640 x 480 pixels; pediatric retinal photograph (wide-field) — 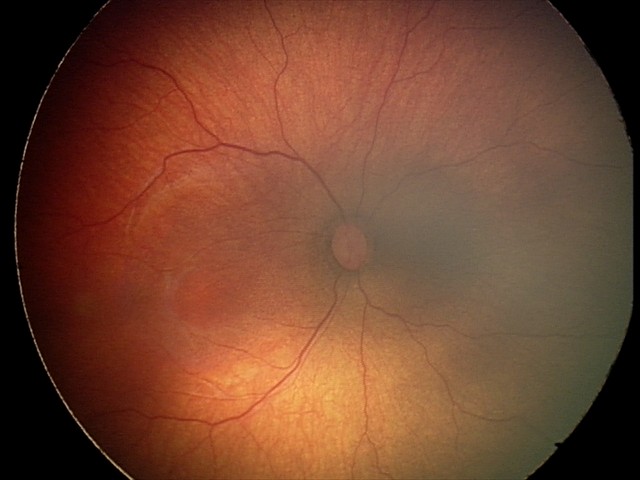

Impression: retinopathy of prematurity (ROP) stage 2.